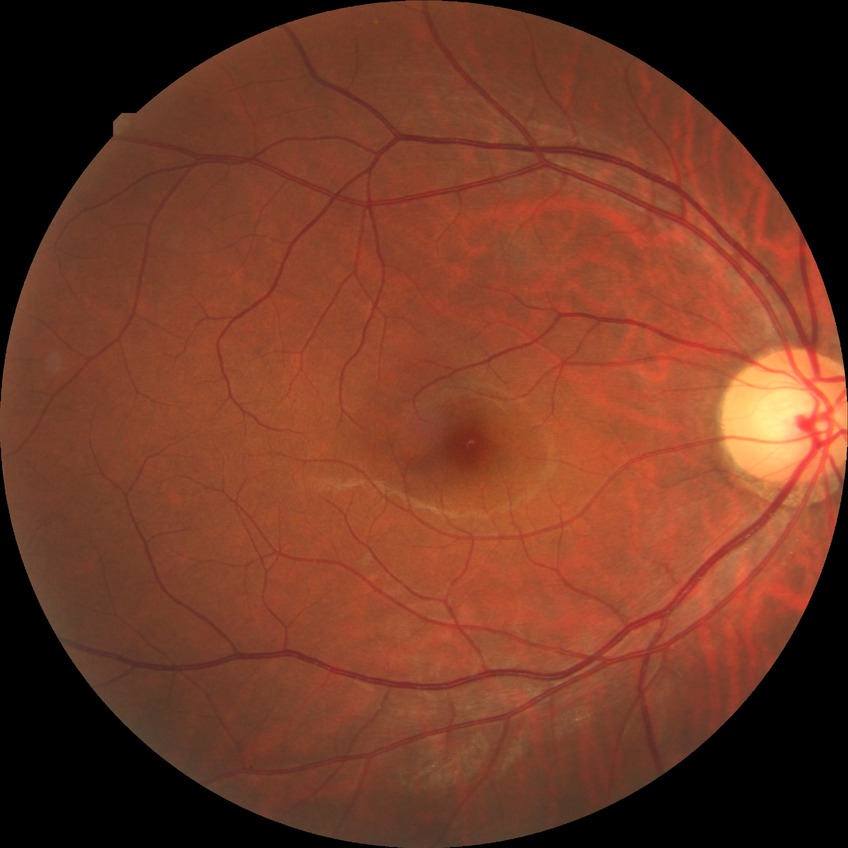 Davis DR grade: NDR.